1932x1932px:
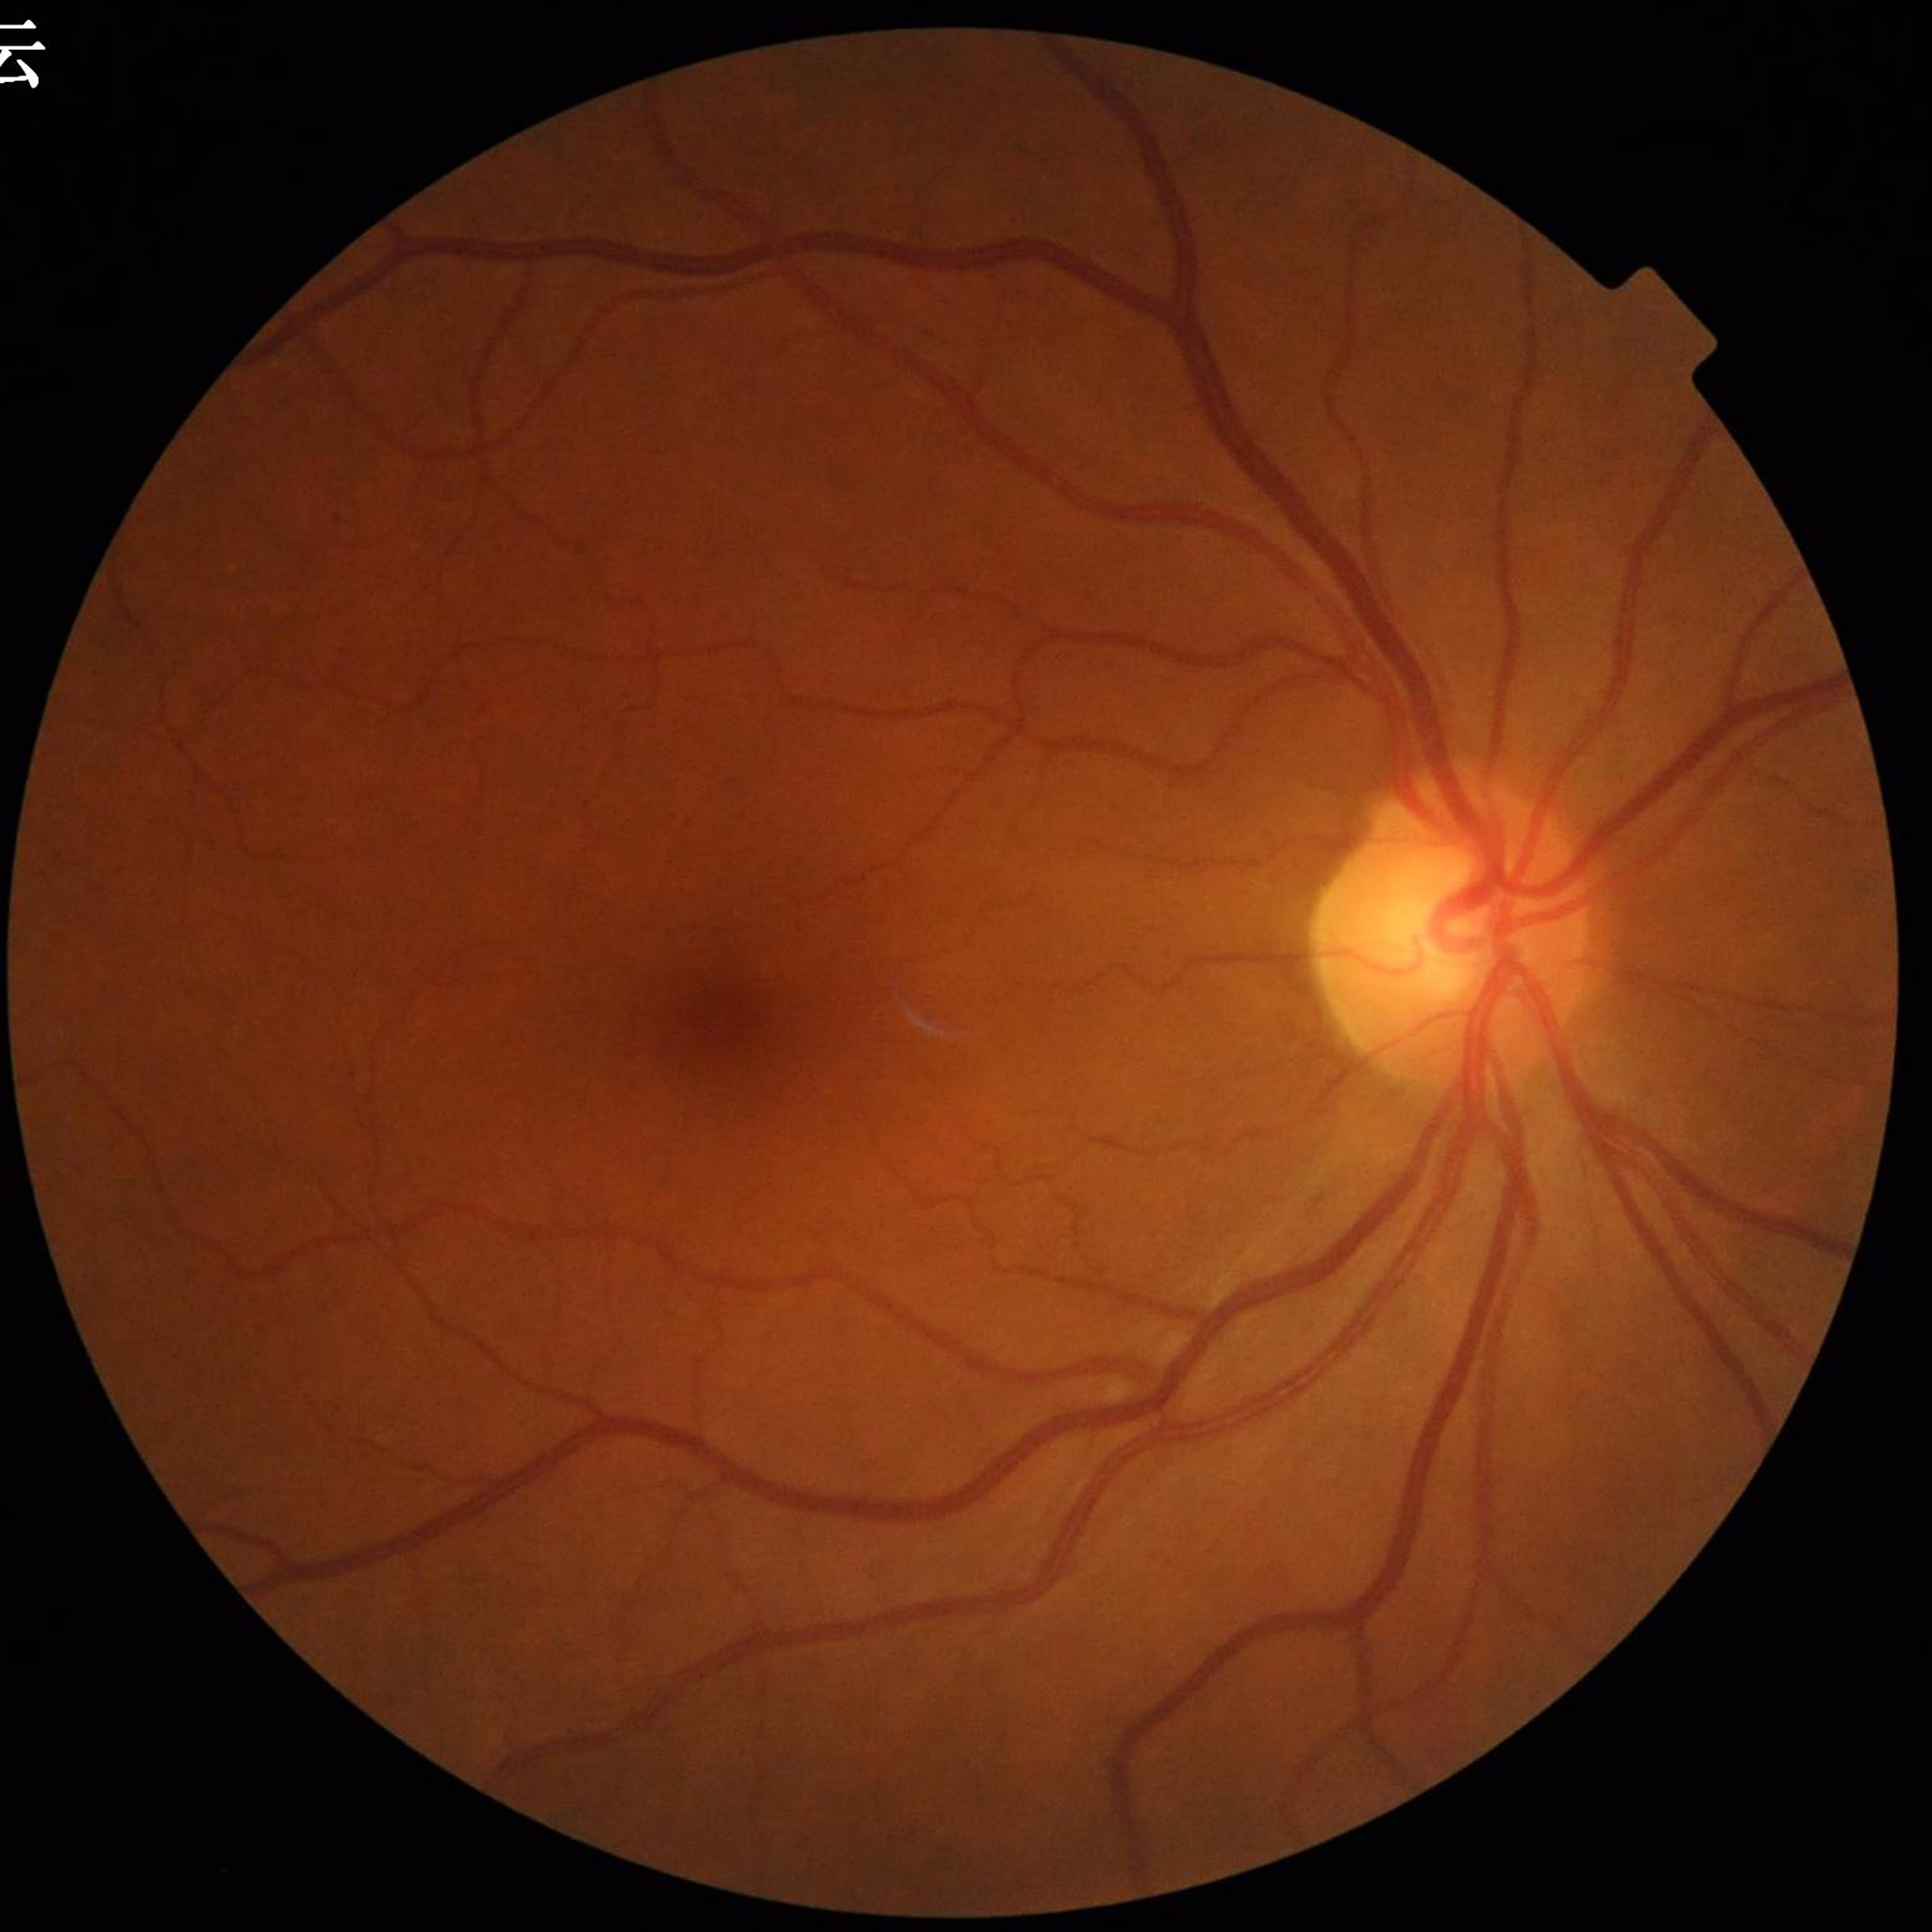 Patient diagnosed with glaucoma.